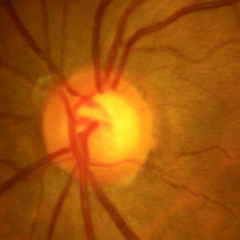
Glaucoma status: no evidence of glaucoma.